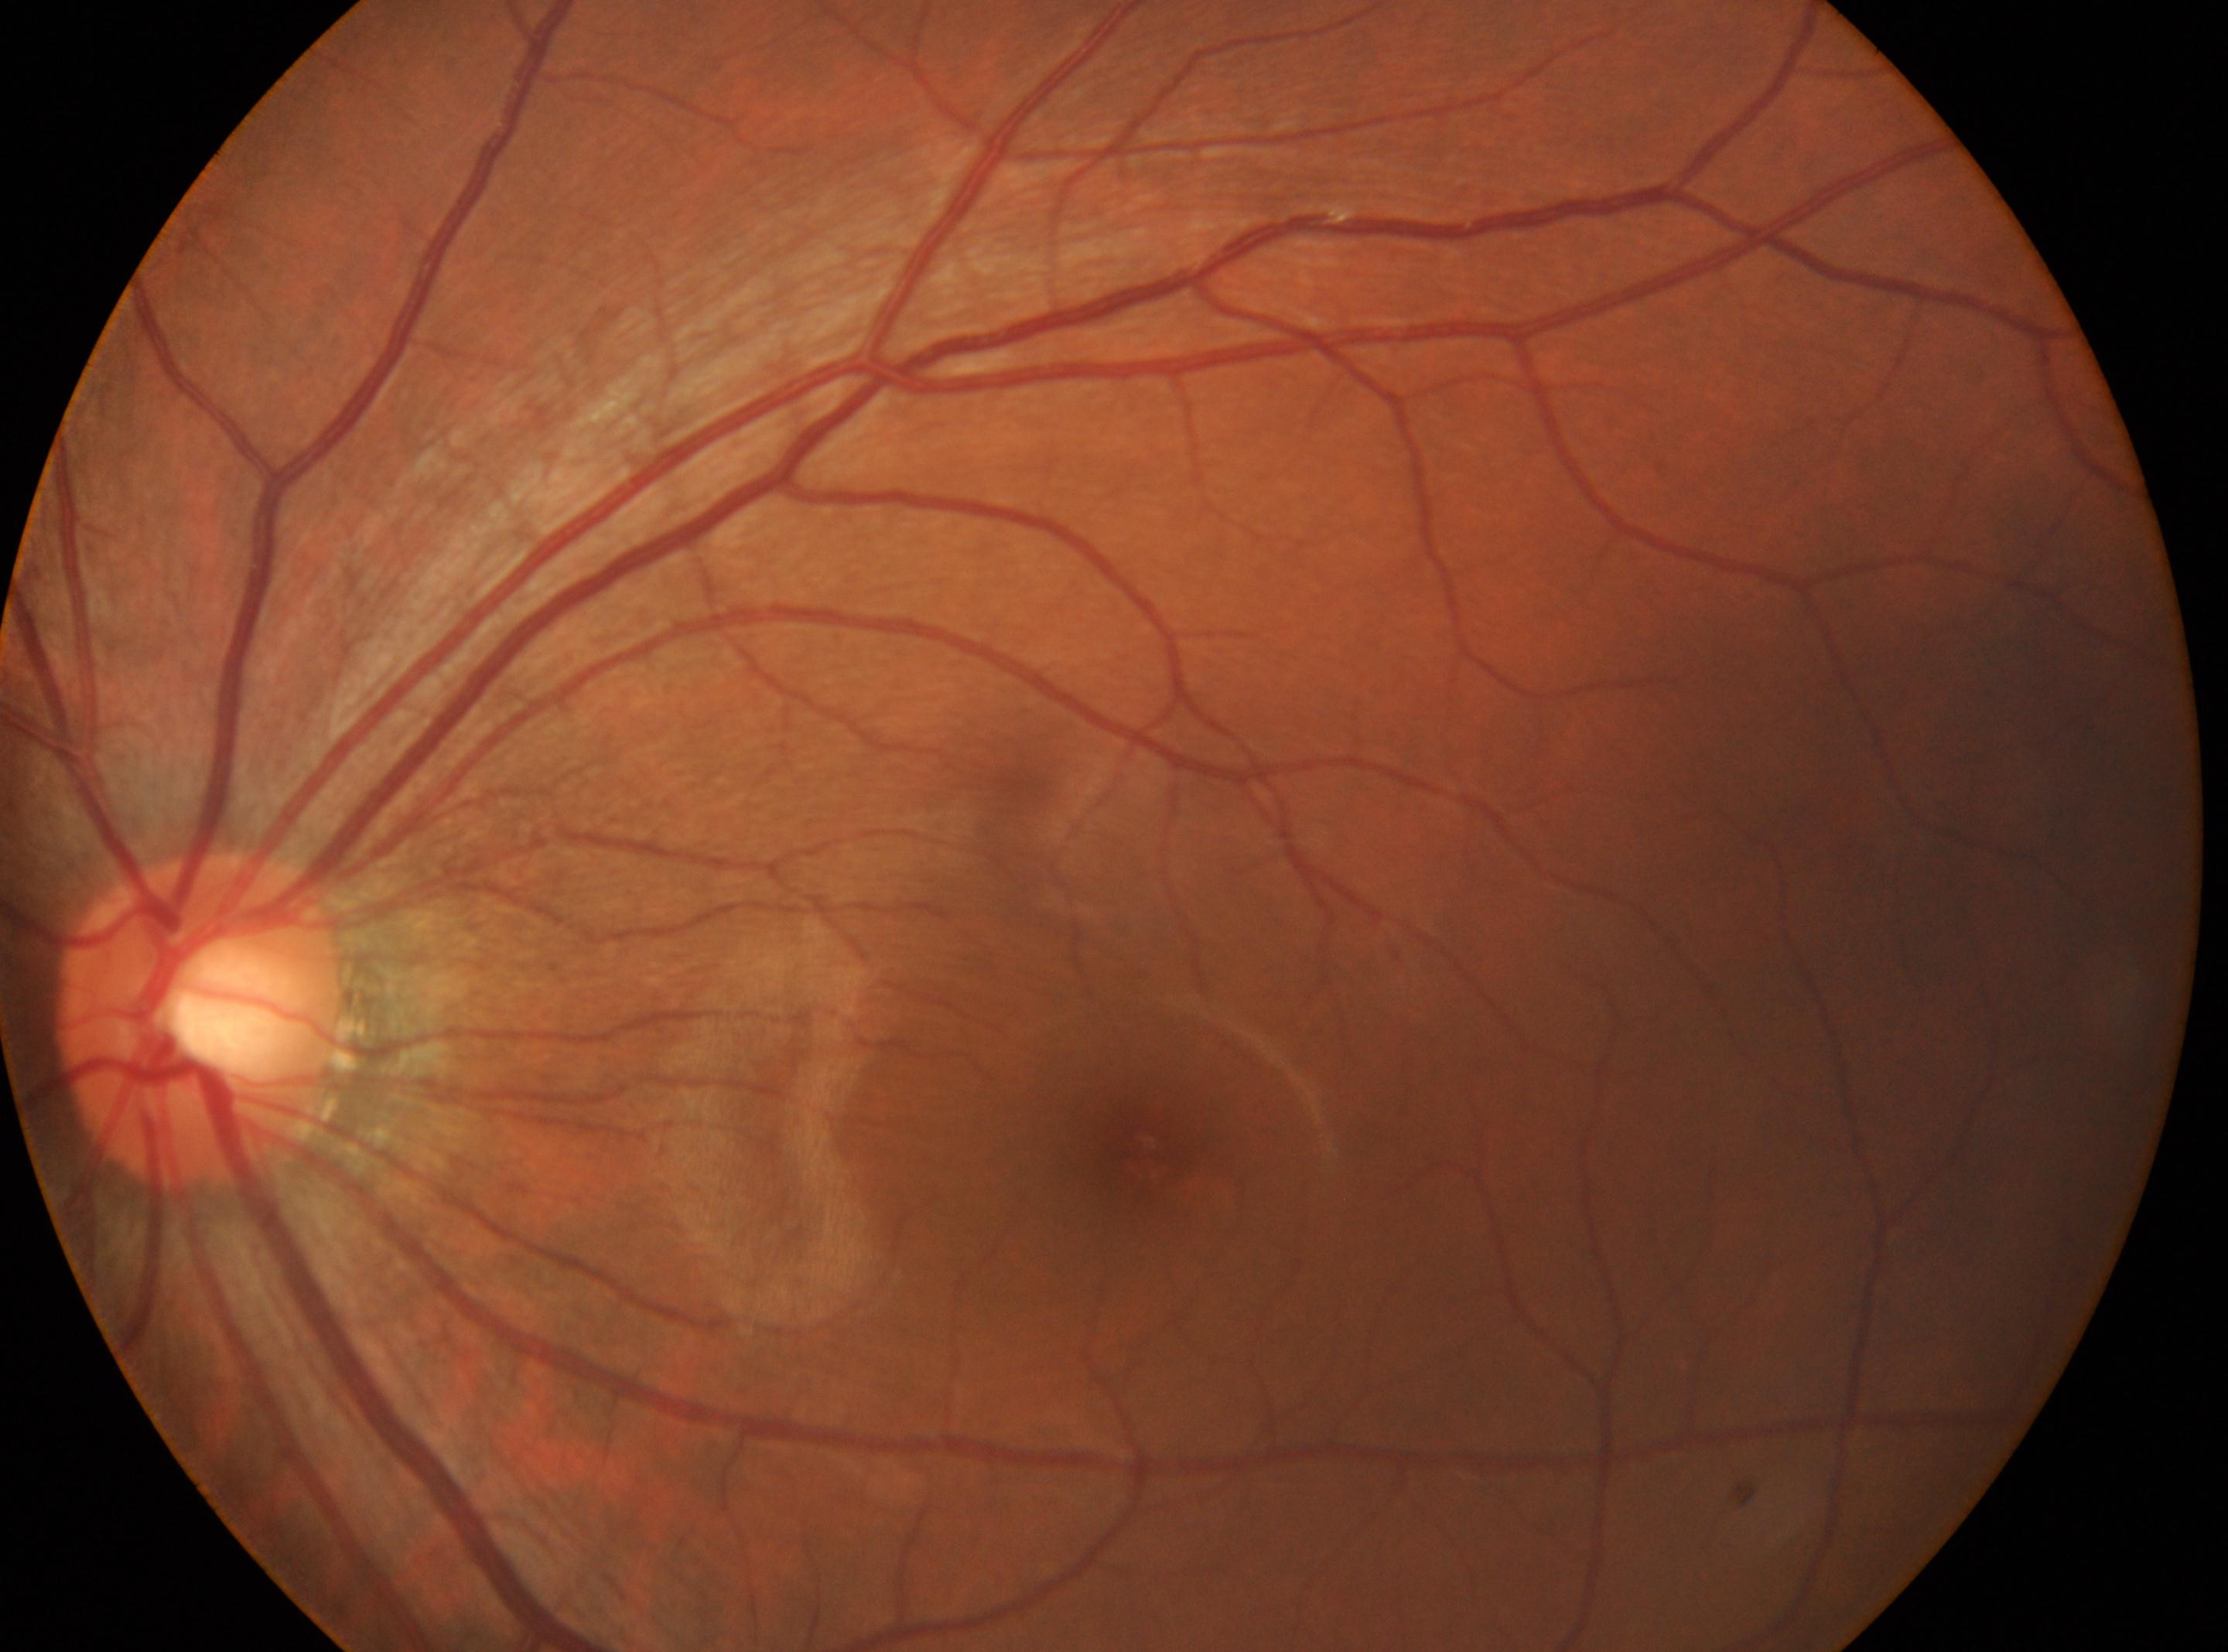 Fovea located at 1145px, 1162px. Diabetic retinopathy (DR) is 0/4. No apparent diabetic retinopathy. Eye: the left eye. The ONH is at 201px, 1018px.